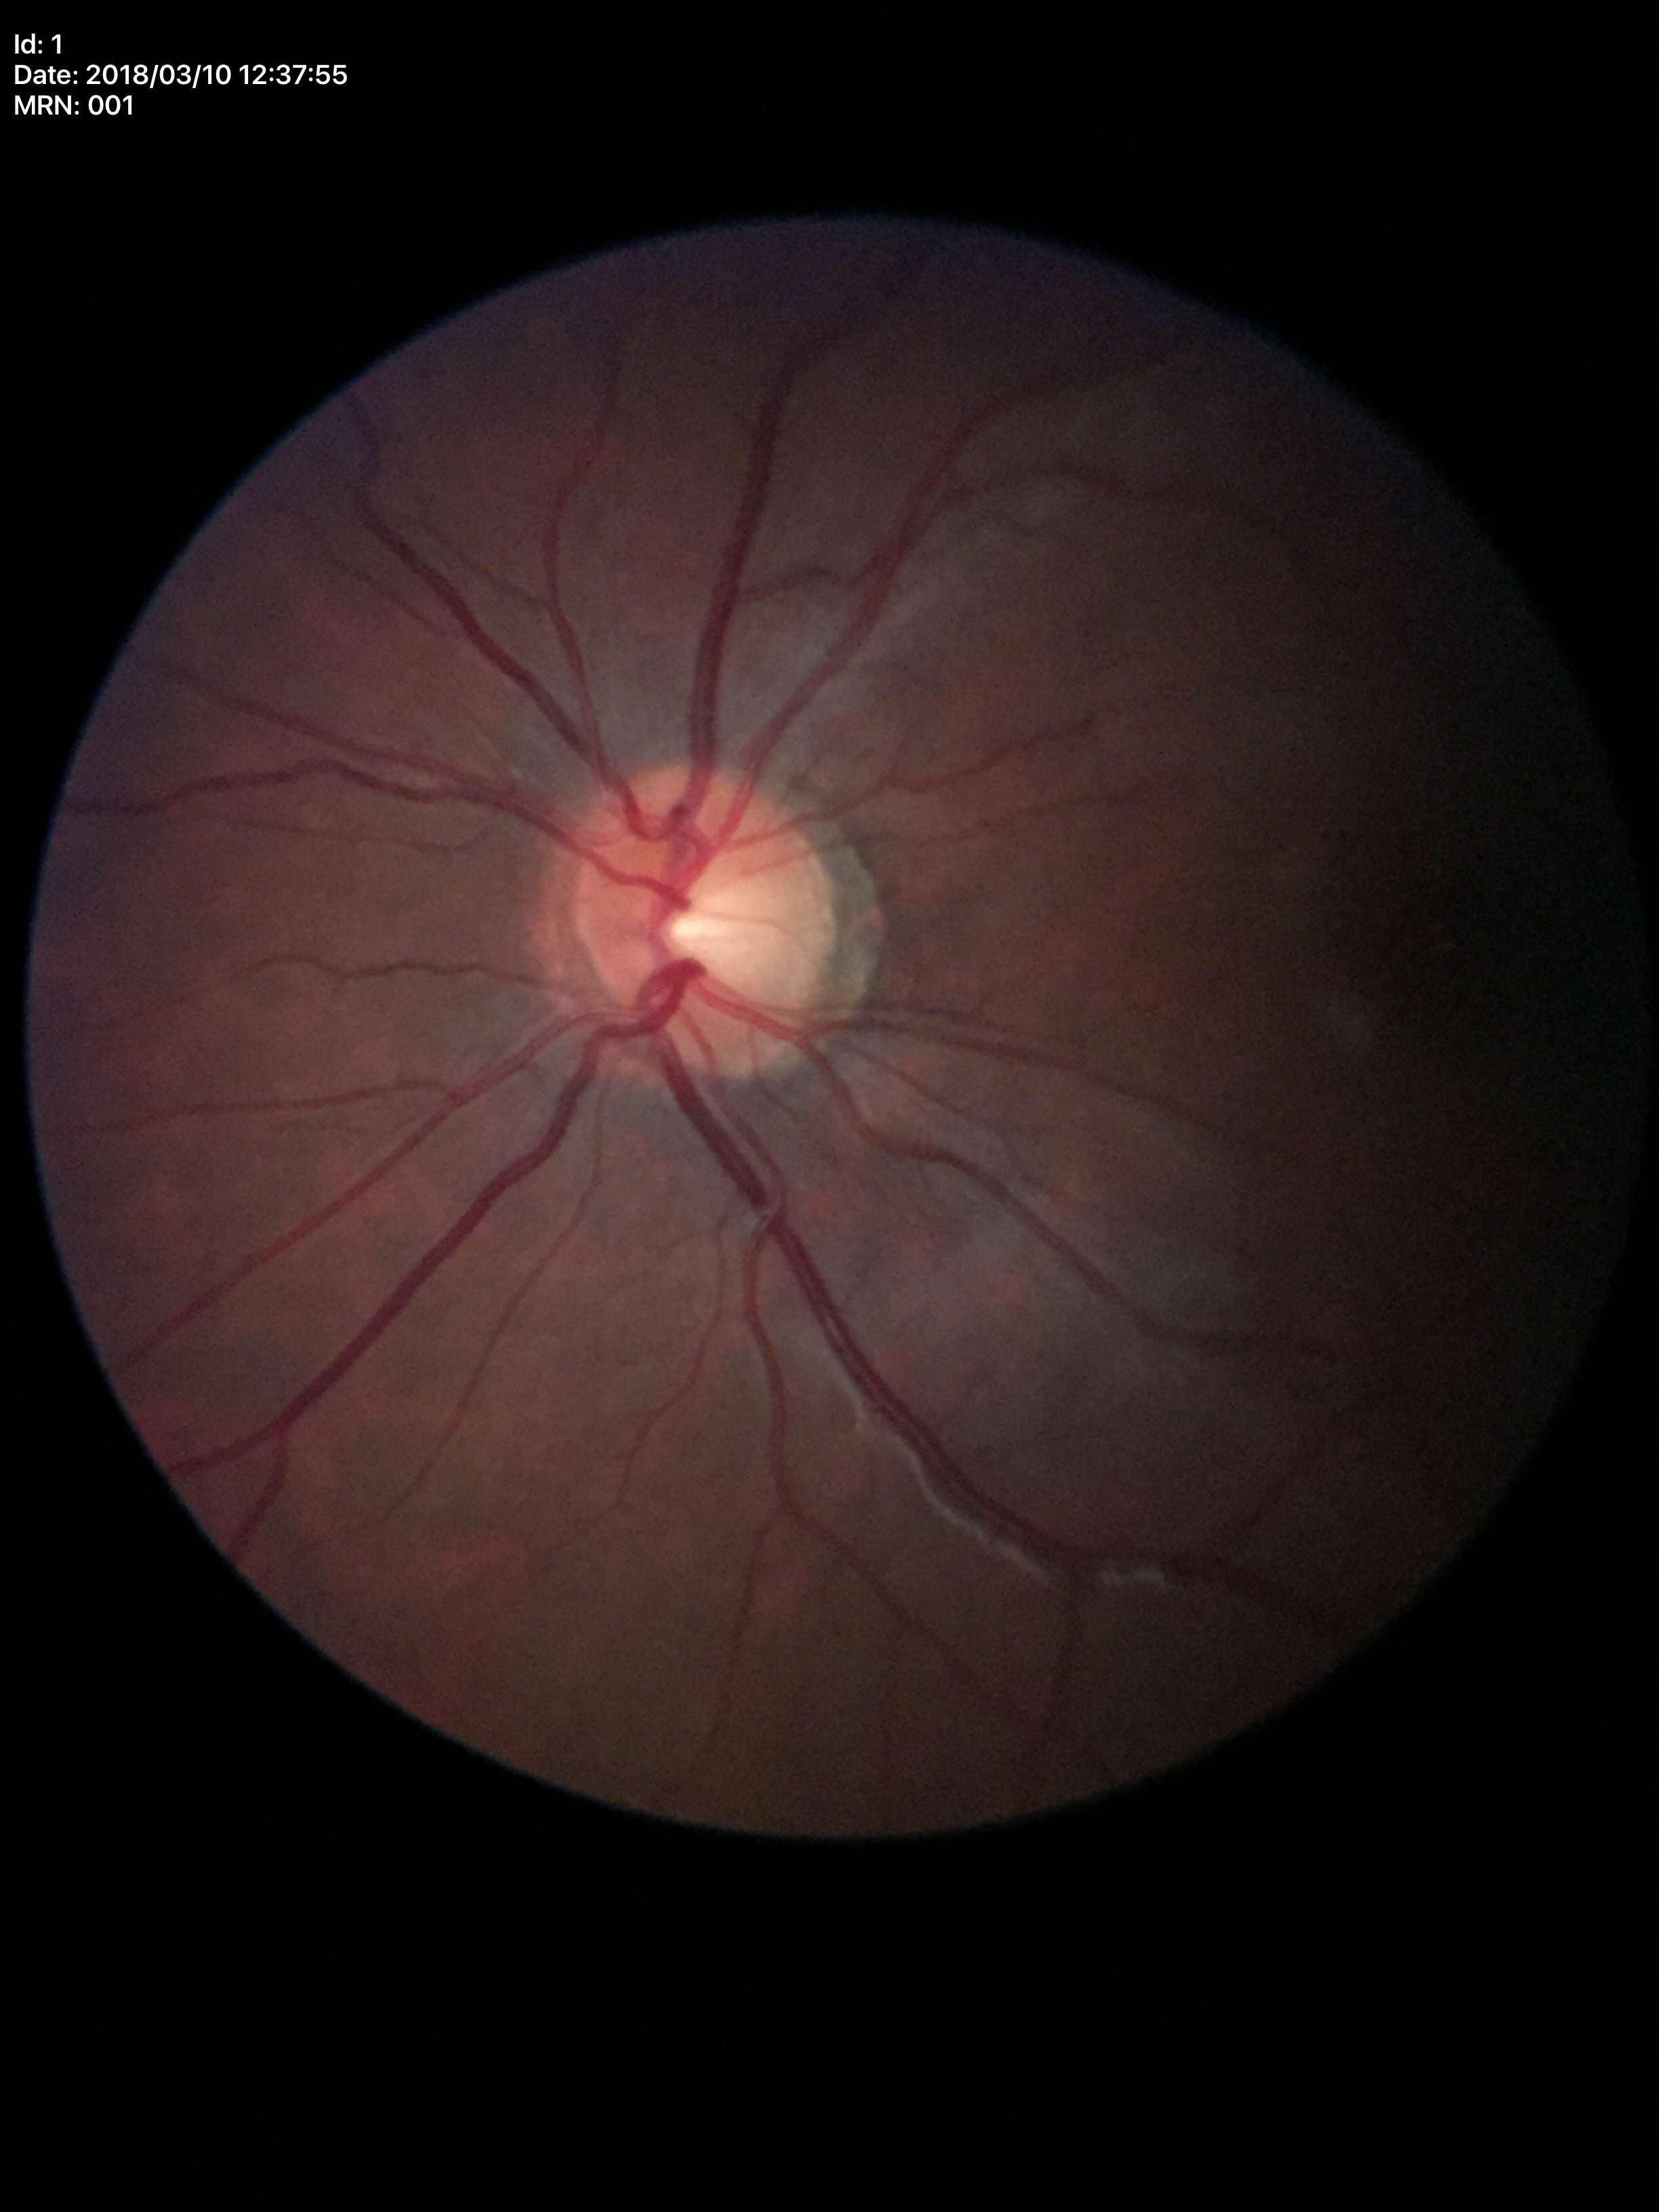 {"glaucoma_decision": "not suspect", "vcdr": "0.51", "acdr": "0.25"}